Pediatric retinal photograph (wide-field); 640x480; captured with the Clarity RetCam 3 (130° field of view): 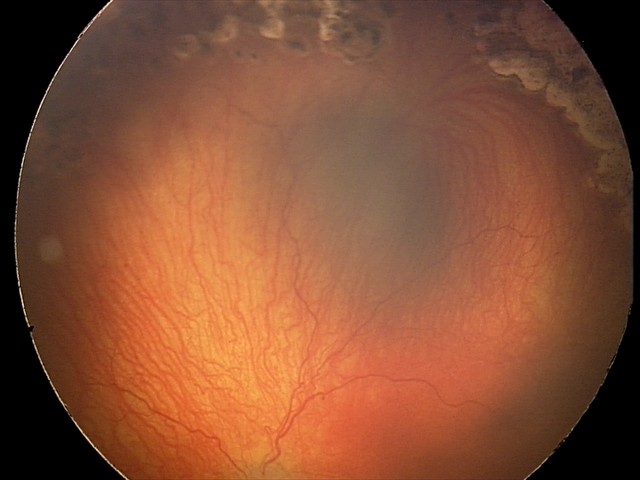 Plus disease present. Diagnosis from this screening exam: aggressive retinopathy of prematurity.